Phoenix ICON, 100° FOV · infant wide-field retinal image · image size 1240x1240:
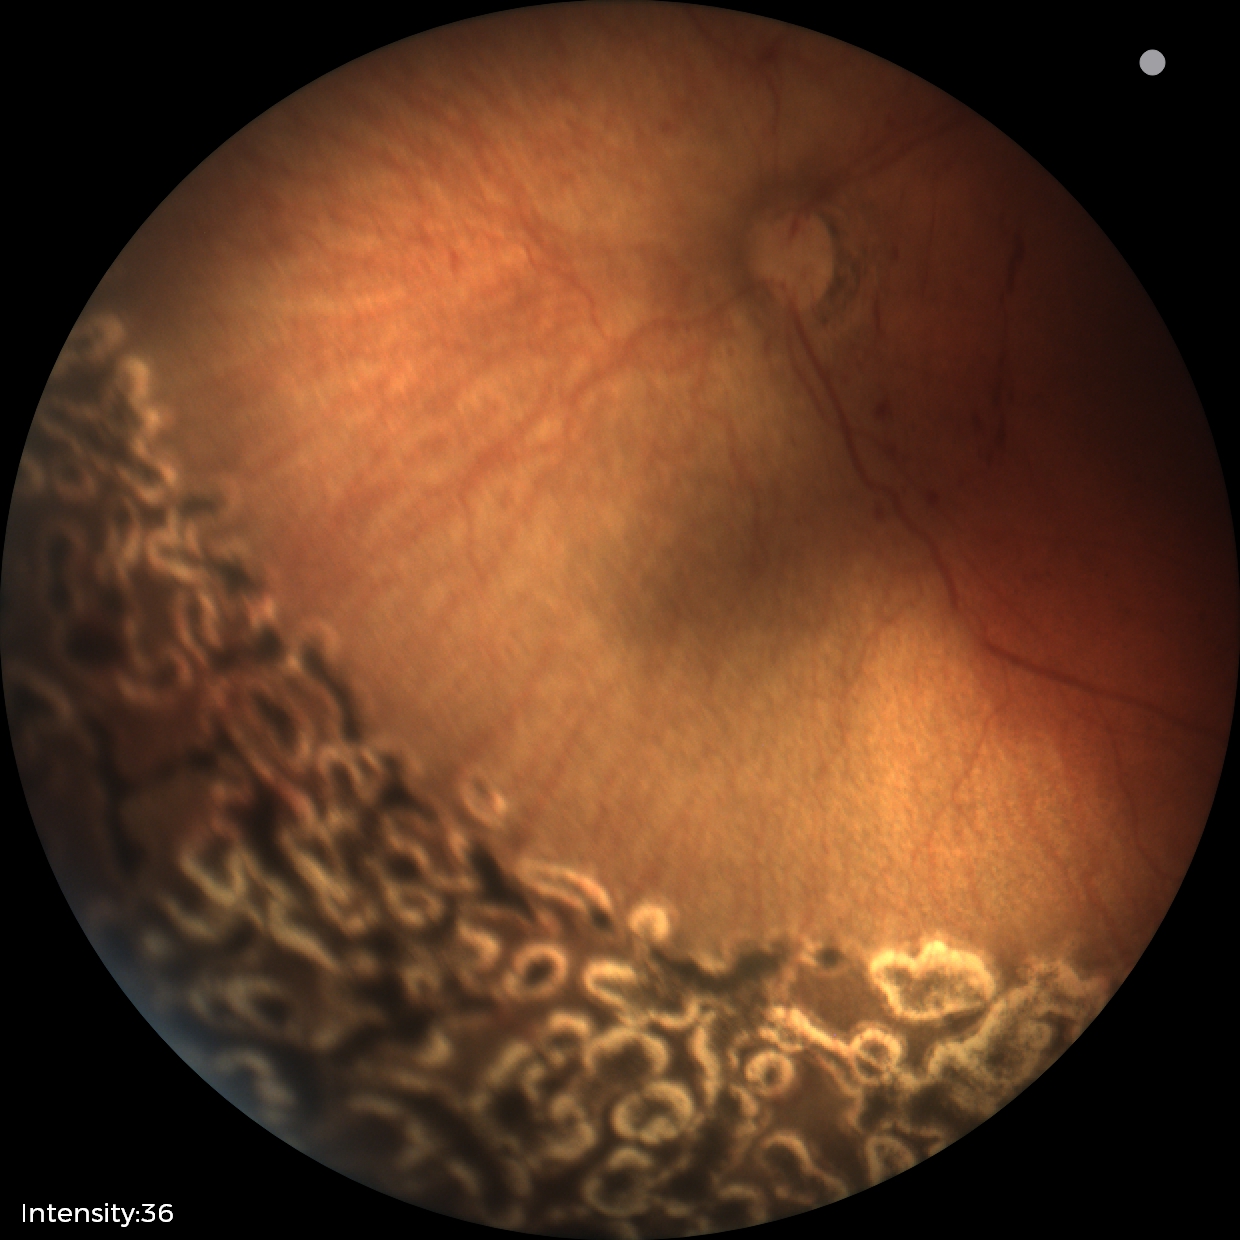
Q: What is the diagnosis from this examination?
A: status post ROP — retinal appearance after treated retinopathy of prematurity
Q: What is the plus-form classification?
A: no plus disease